Diabetic retinopathy graded by the modified Davis classification · 848 by 848 pixels — 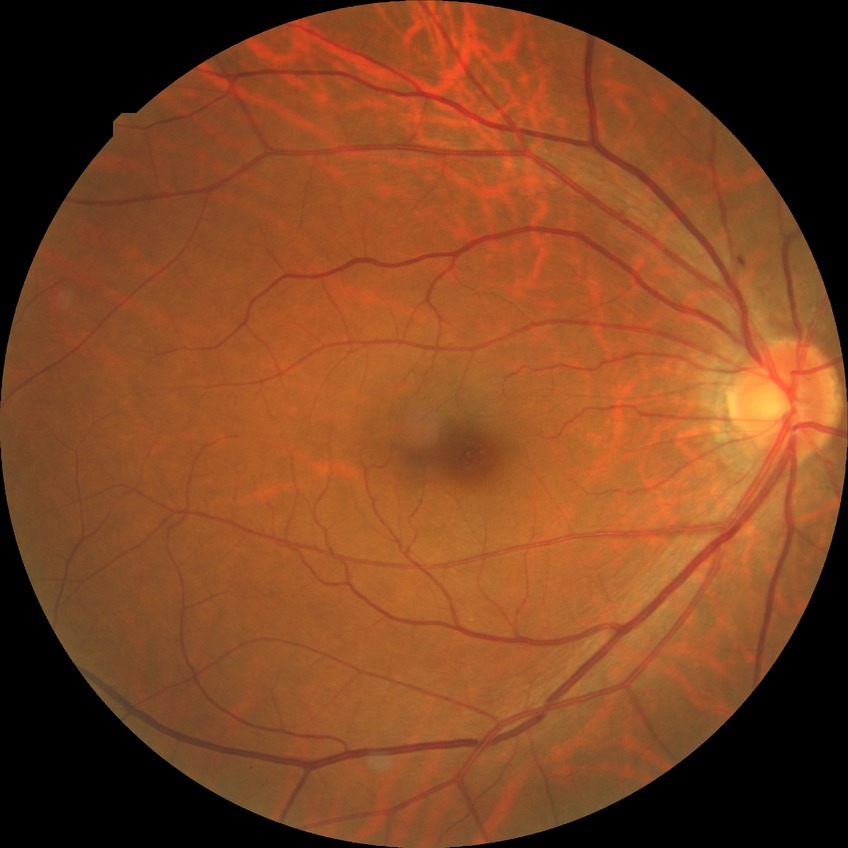
diabetic retinopathy (DR): simple diabetic retinopathy (SDR), DR class: non-proliferative diabetic retinopathy.